Captured with the Clarity RetCam 3 (130° field of view). 640 x 480 pixels. Wide-field fundus image from infant ROP screening — 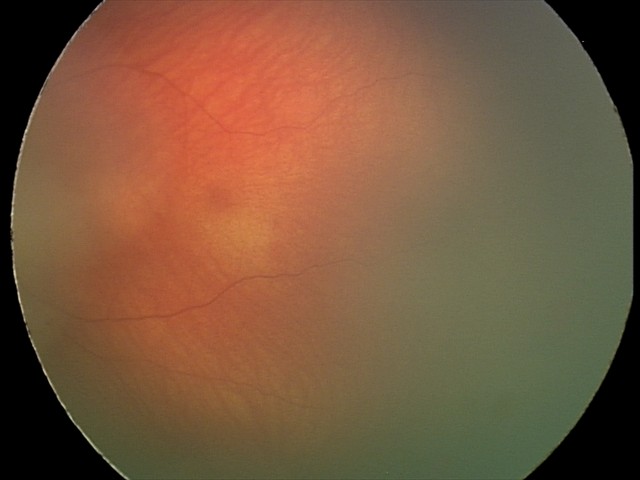 Screening examination diagnosed as physiological.